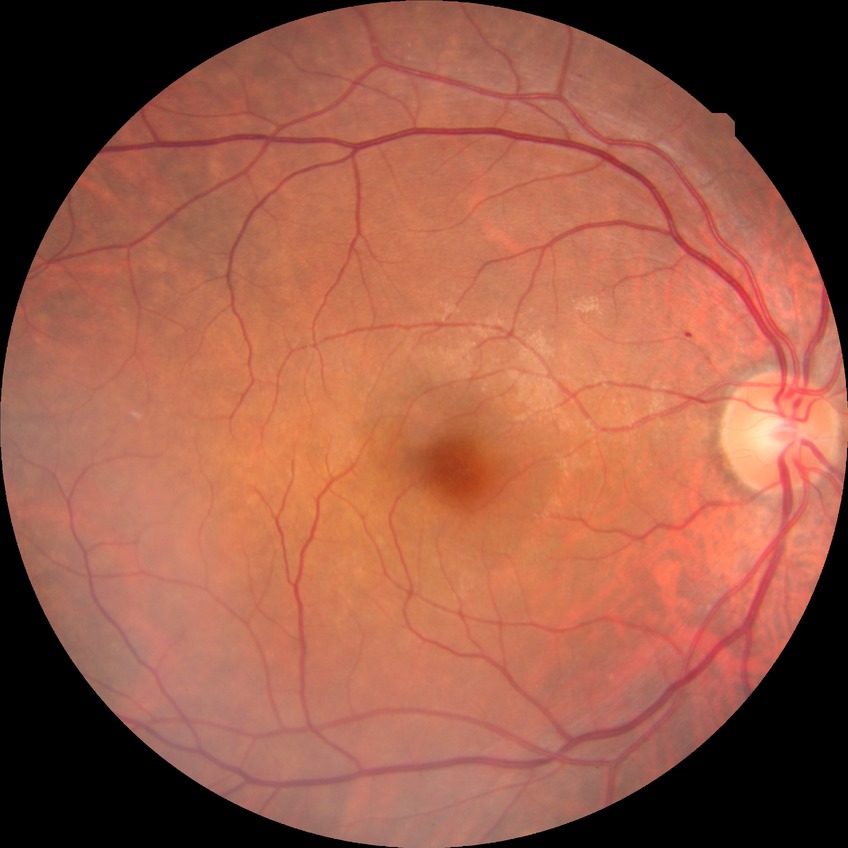
DR grade is NDR.